1659 by 2212 pixels; color fundus photograph: 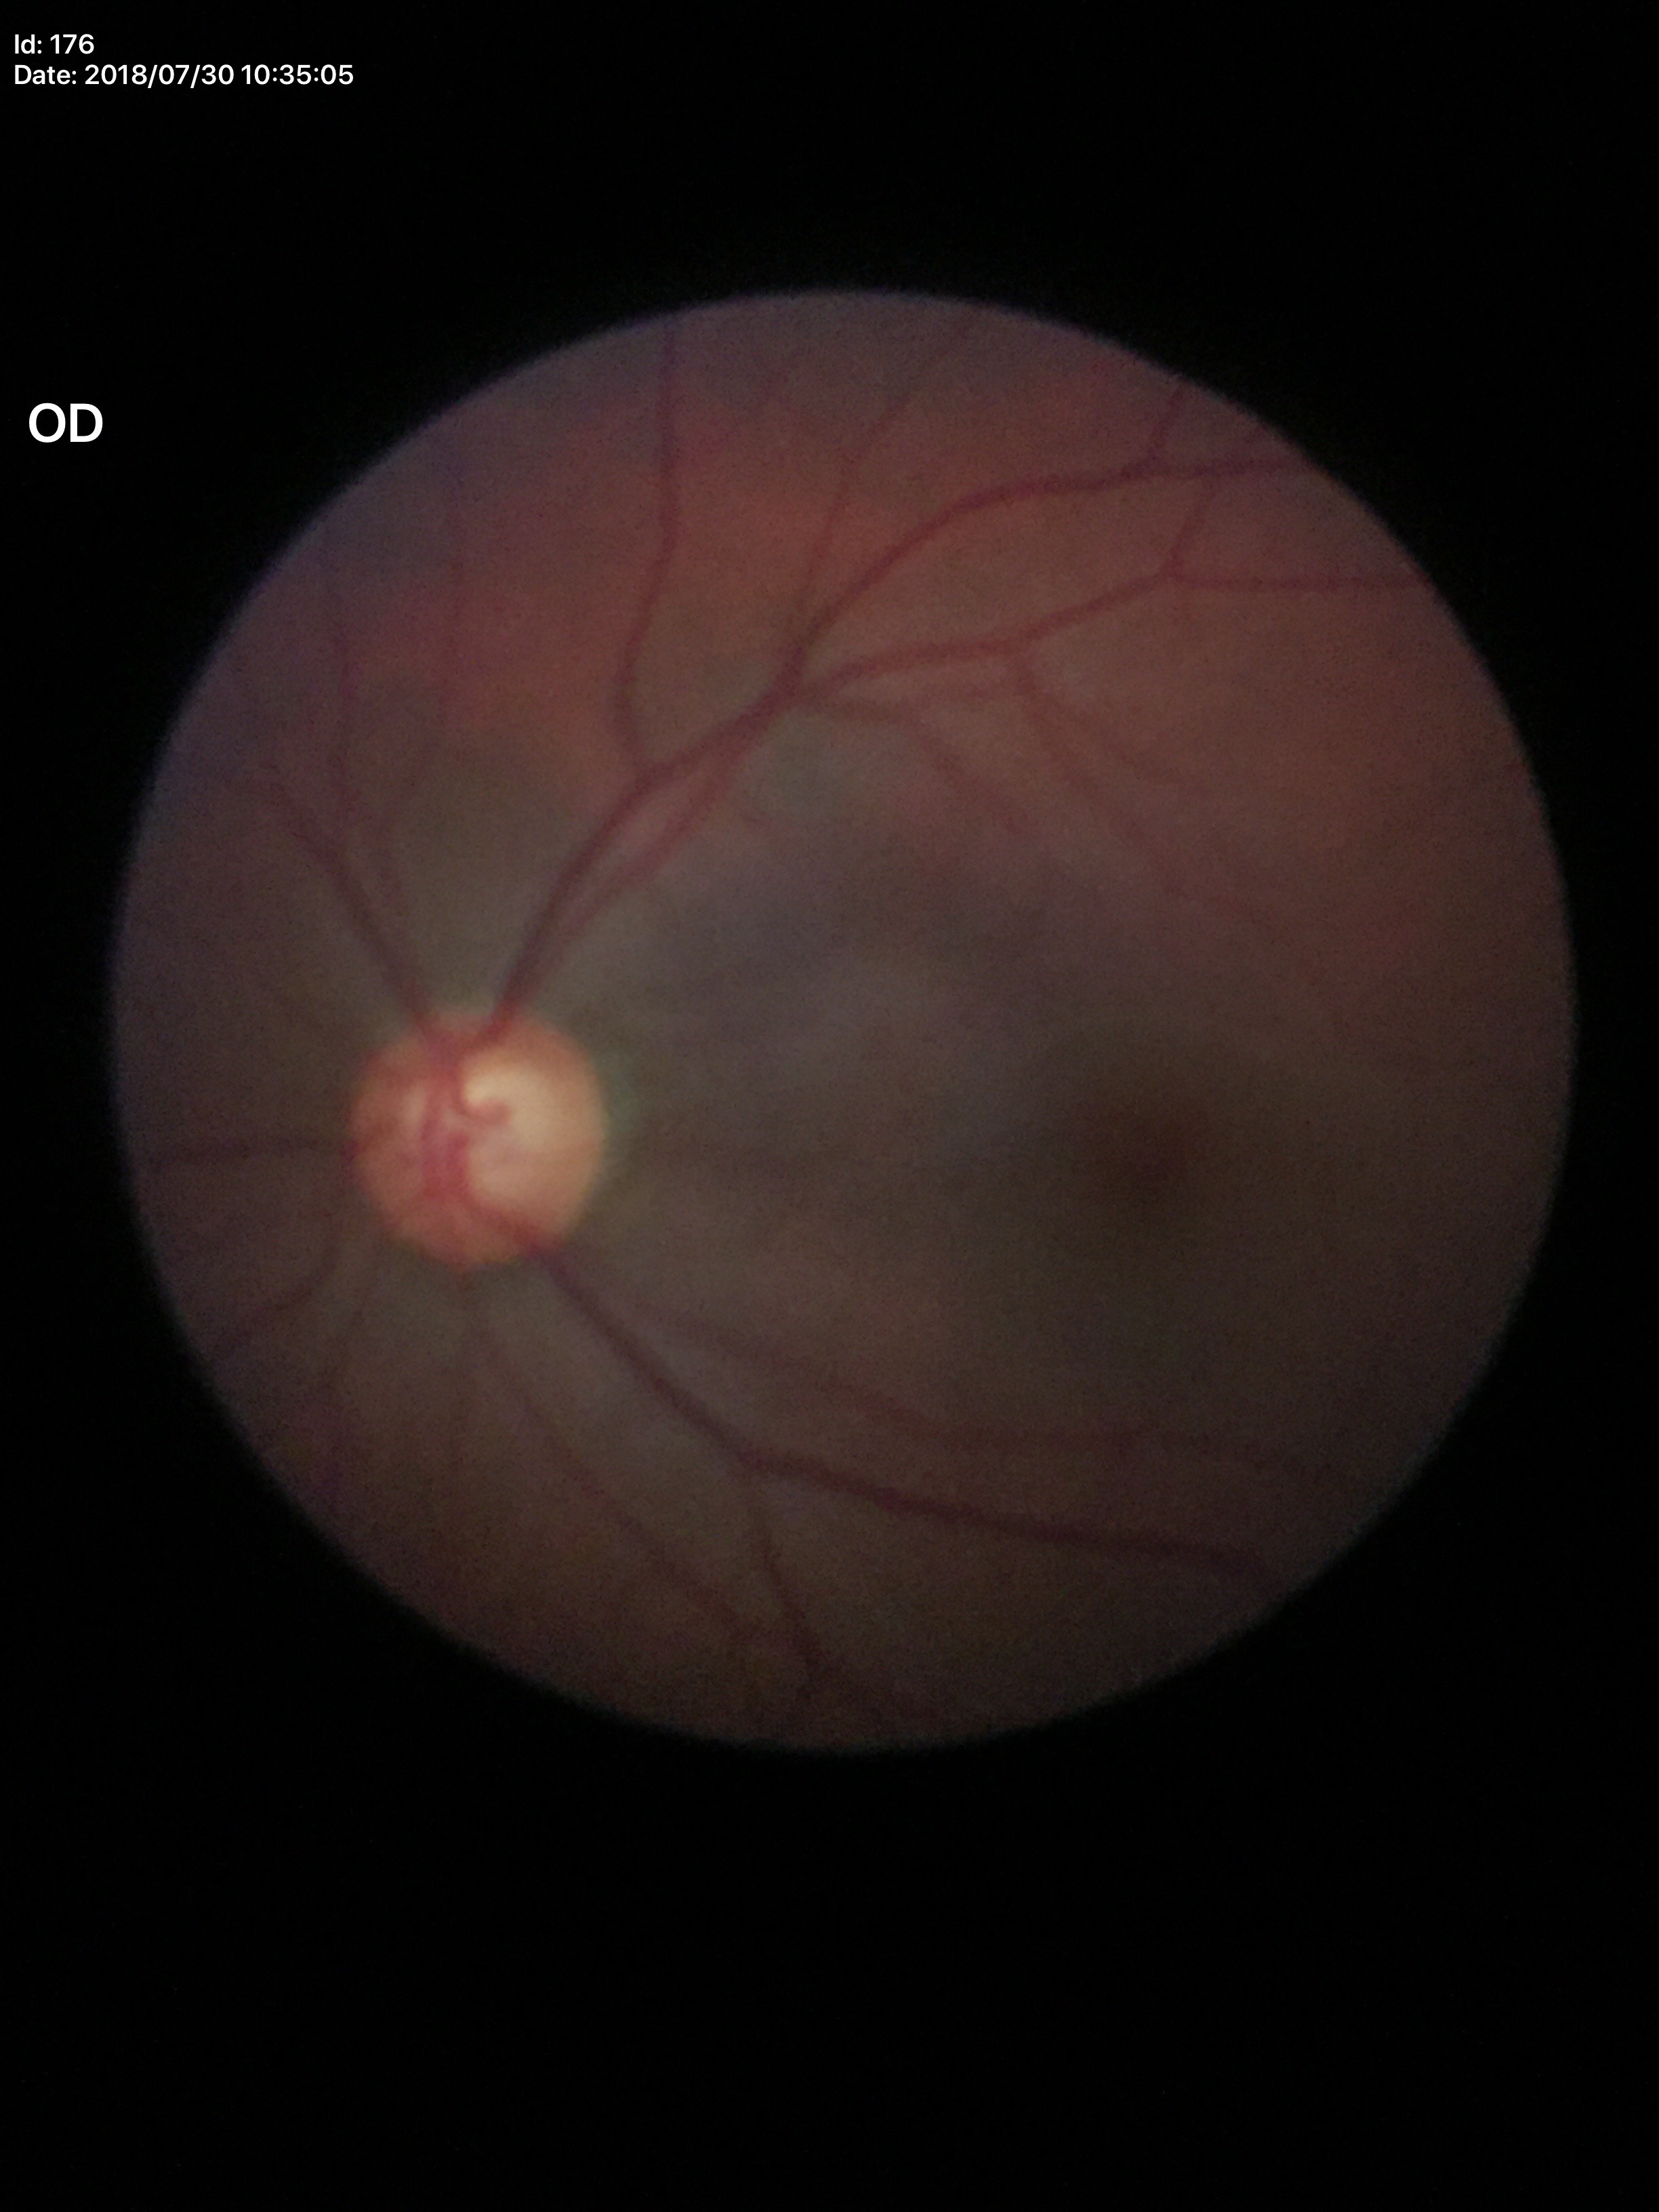 * horizontal CDR (HCDR) · 0.63
* area CDR (ACDR) · 0.38
* vertical CDR (VCDR) · 0.59
* Glaucoma evaluation · suspect